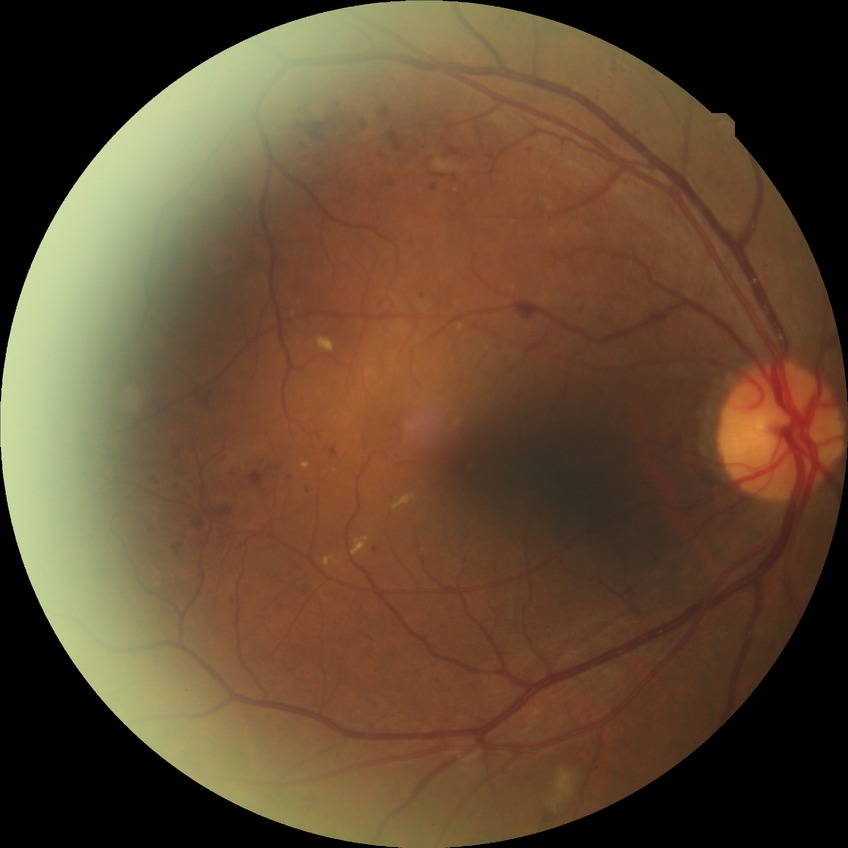

Diabetic retinopathy (DR) is pre-proliferative diabetic retinopathy (PPDR).